Wide-field contact fundus photograph of an infant. 1240 by 1240 pixels
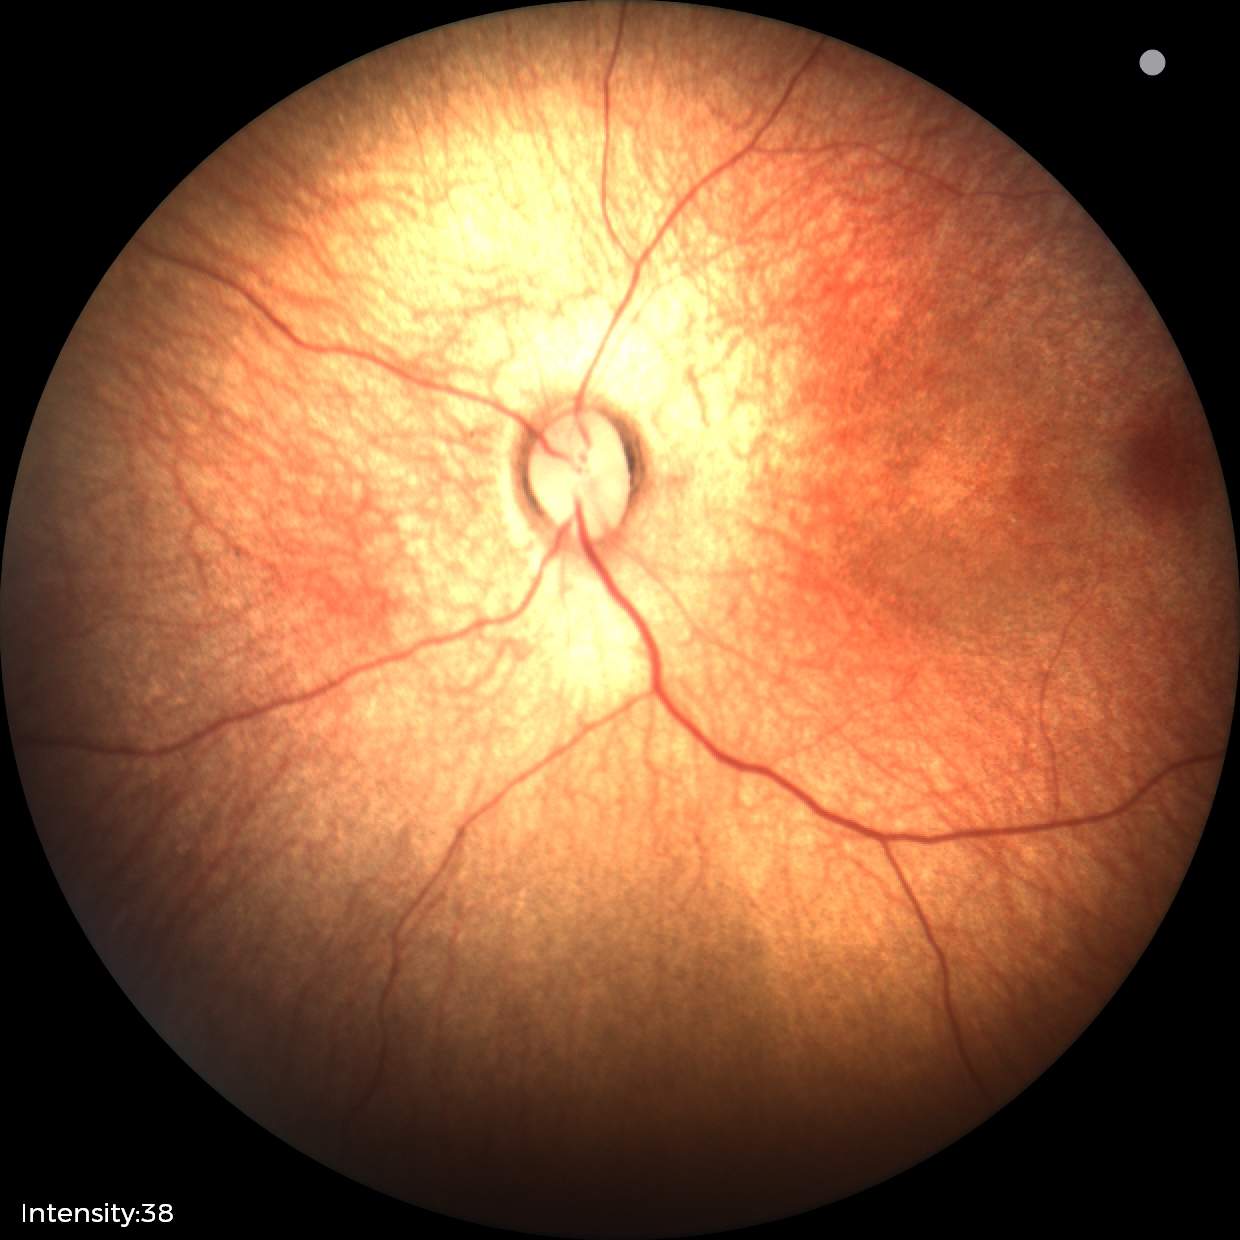 Examination with physiological retinal findings.